Retinal fundus photograph; 50° FOV.
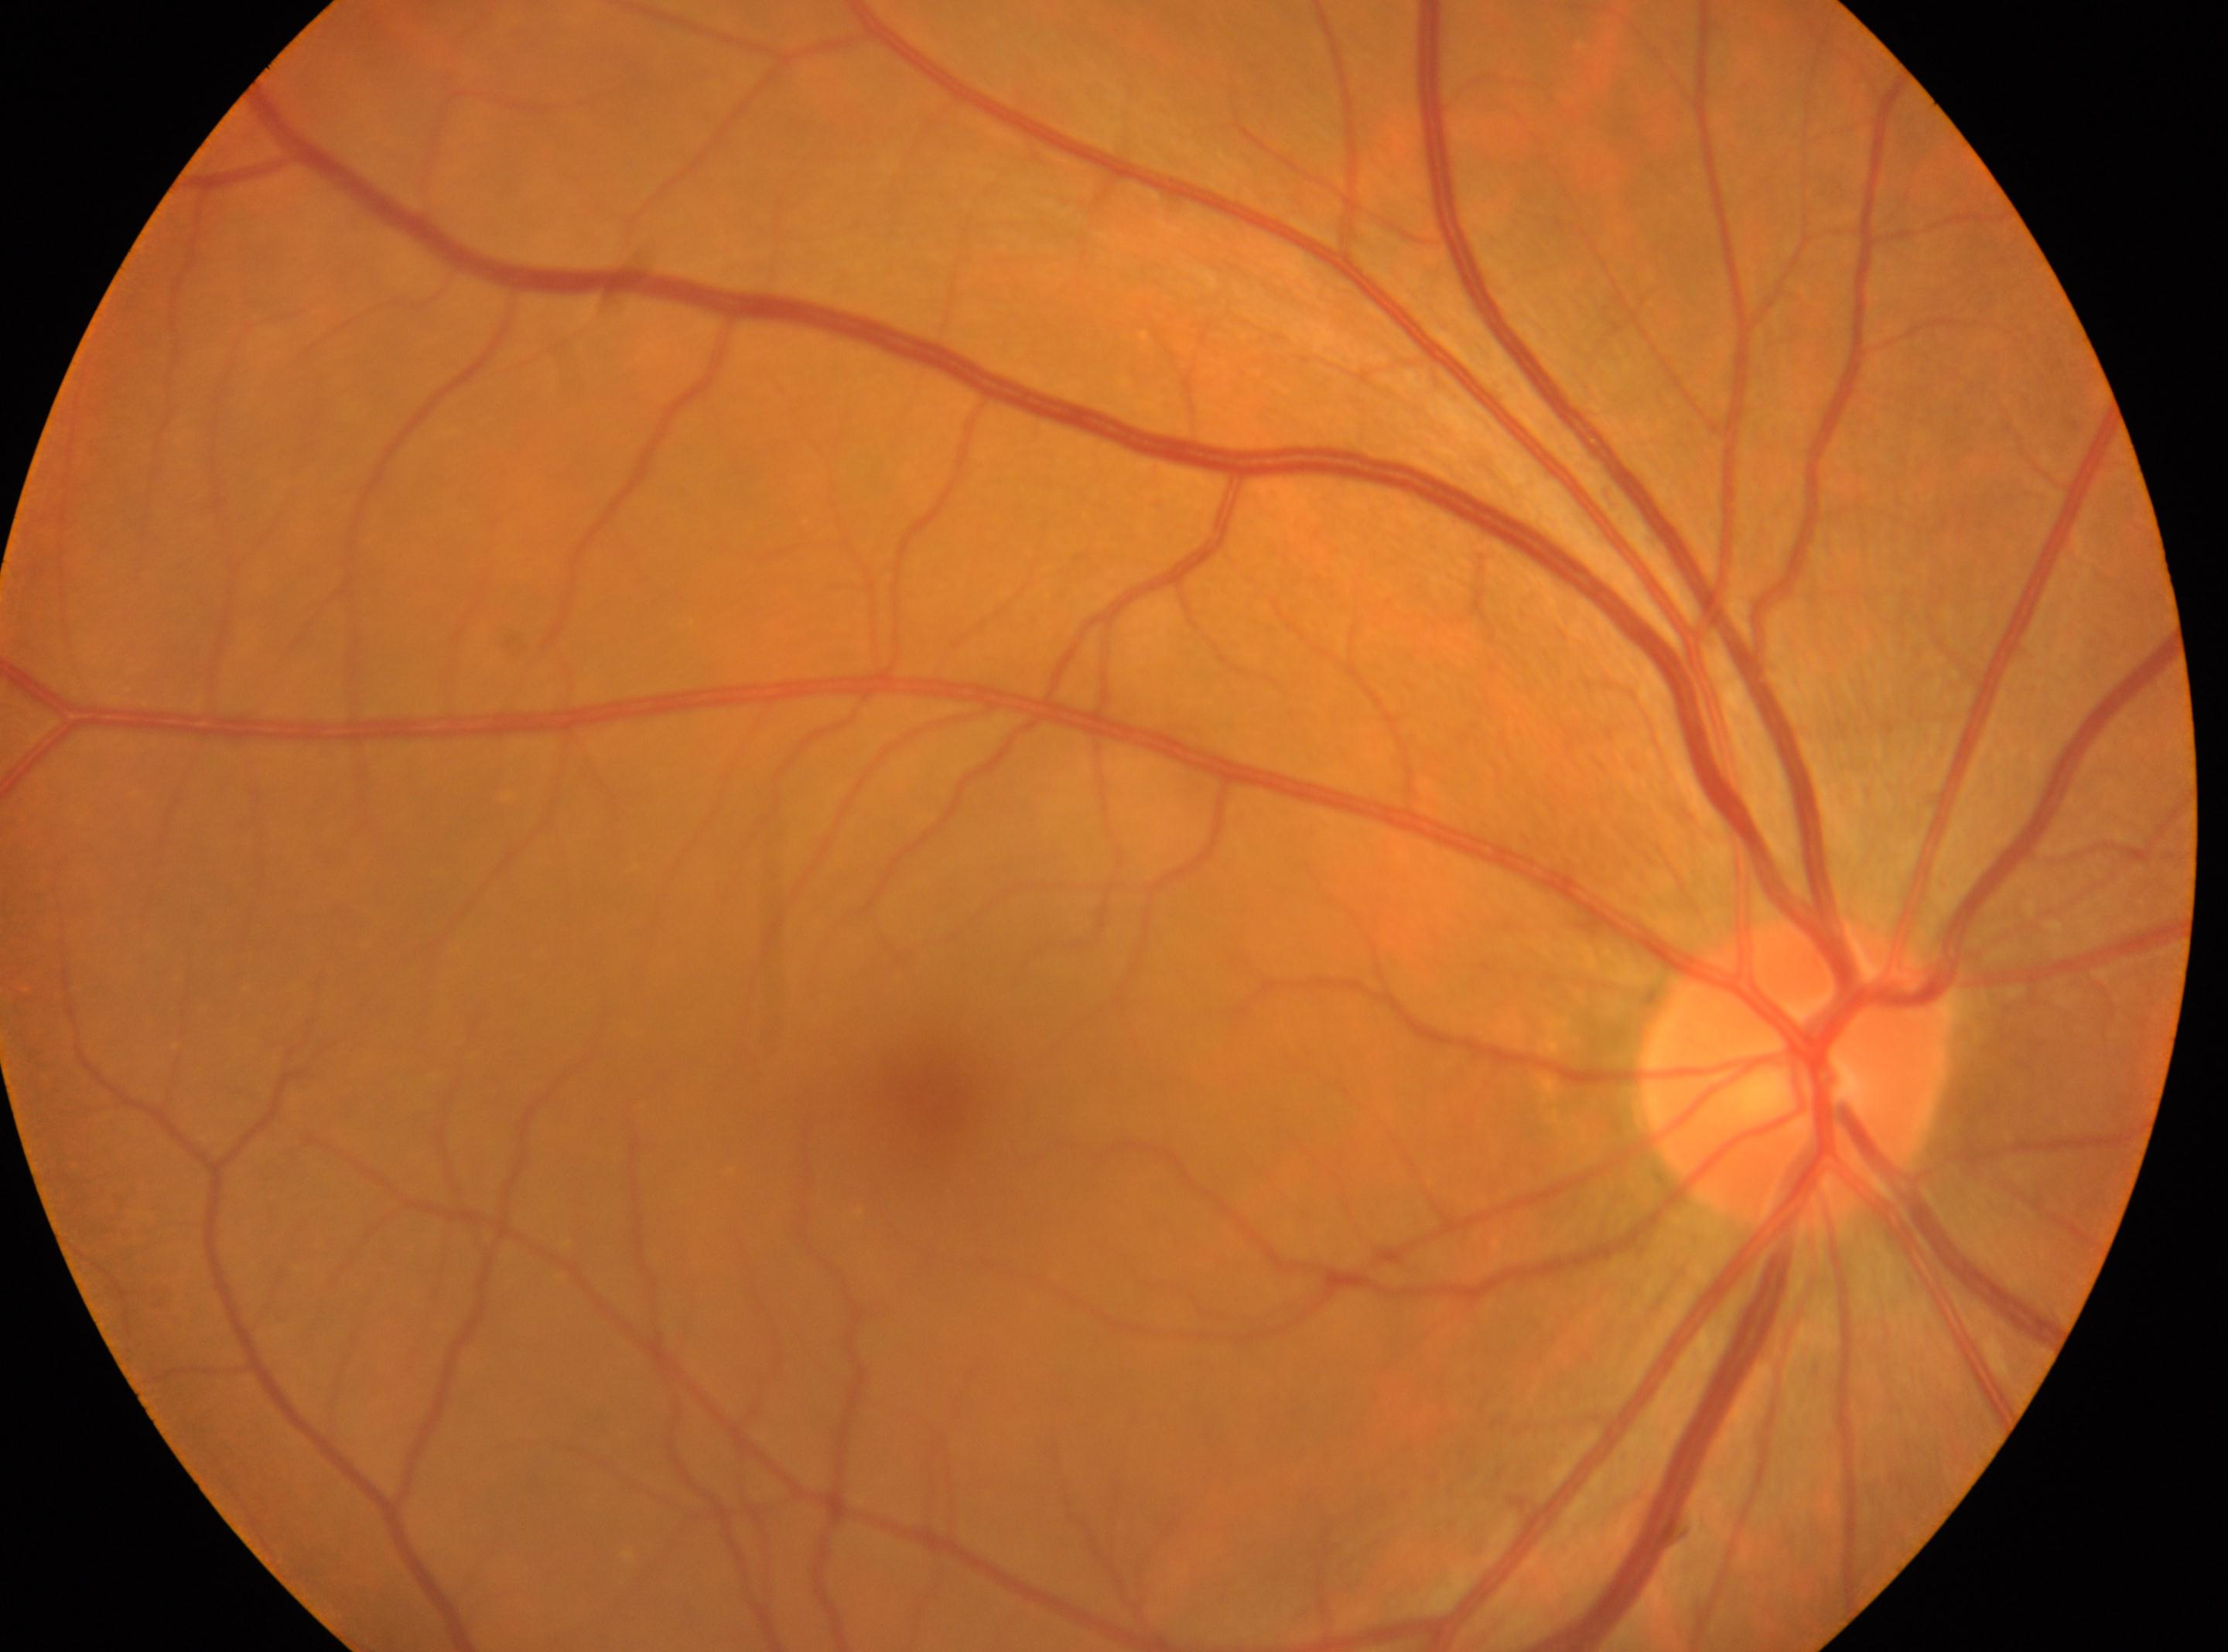
dr_grade: 0/4
optic_disc: [1795, 1073]
eye: right
fovea: [930, 1103]
dr_impression: No apparent diabetic retinopathy